Graded on the modified Davis scale; 848x848px; no pharmacologic dilation — 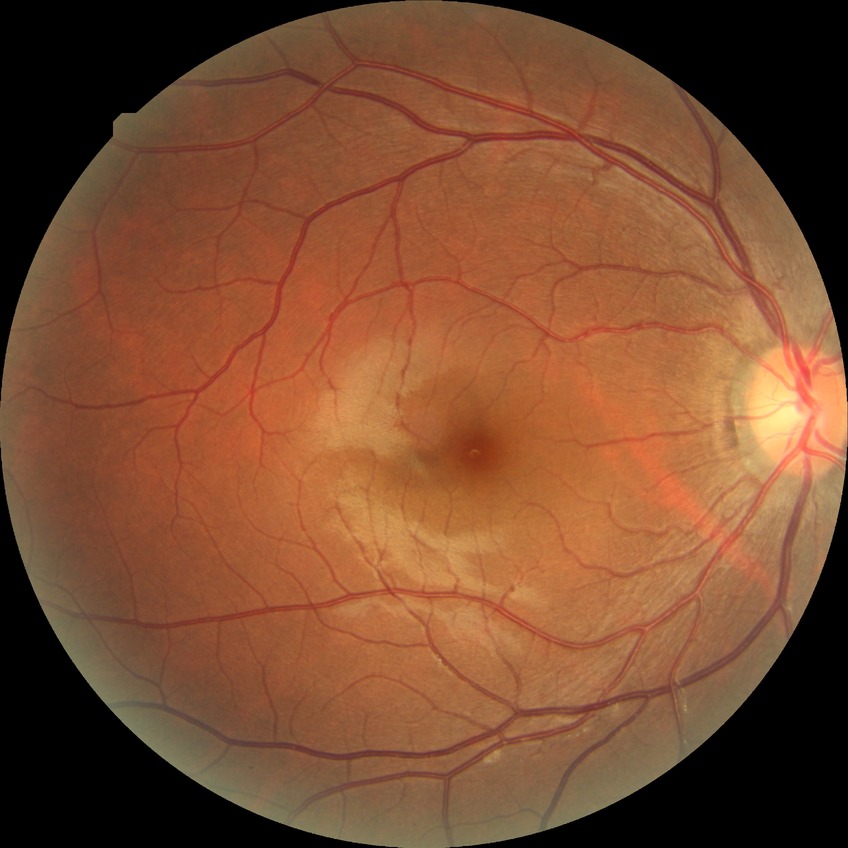 Diabetic retinopathy (DR): NDR (no diabetic retinopathy).